1380x1382px. 45° FOV. Fundus photo
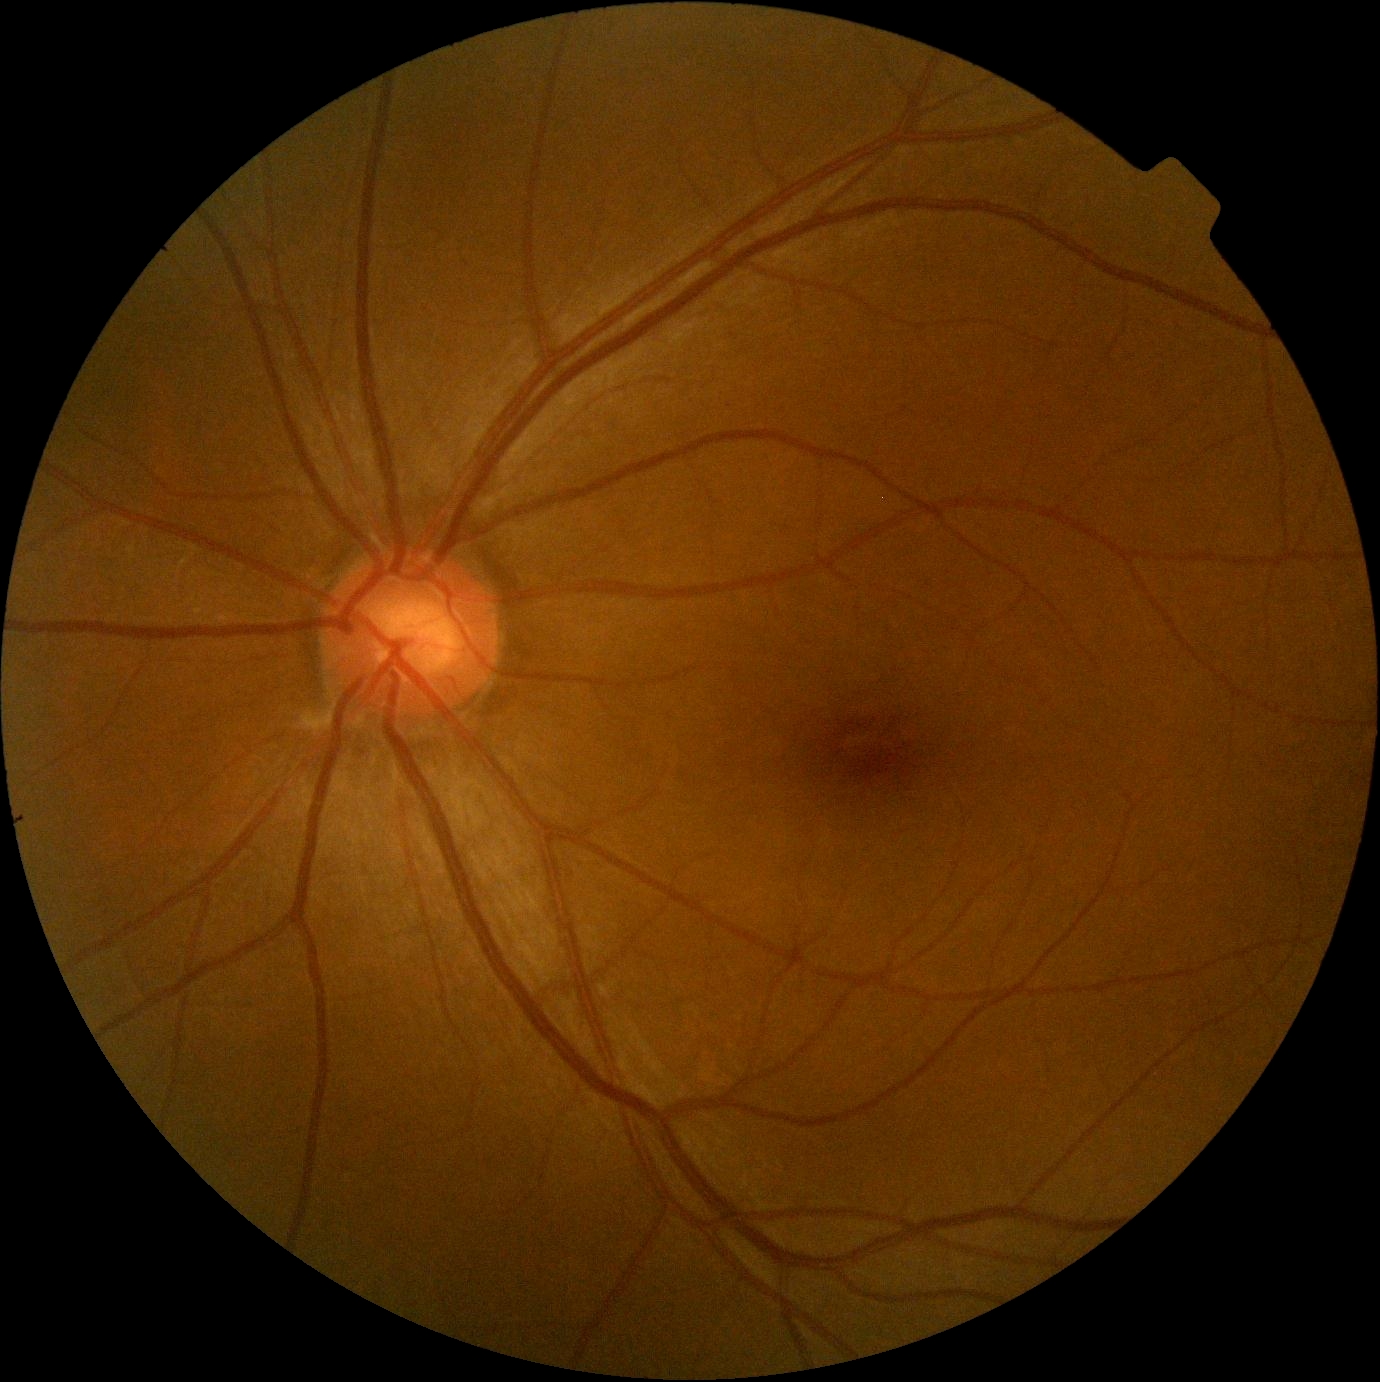
DR stage: grade 0 — no visible signs of diabetic retinopathy.